Image size 640x480; 130° field of view (Clarity RetCam 3); RetCam wide-field infant fundus image.
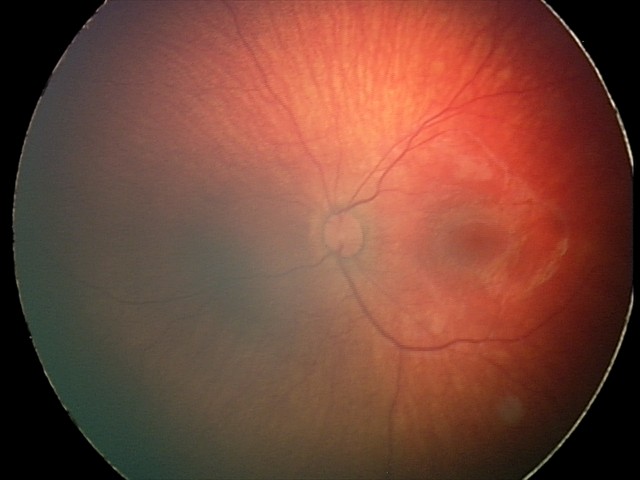 Impression = retinal hemorrhages.